Infant wide-field retinal image. Acquired on the Phoenix ICON. 1240x1240px.
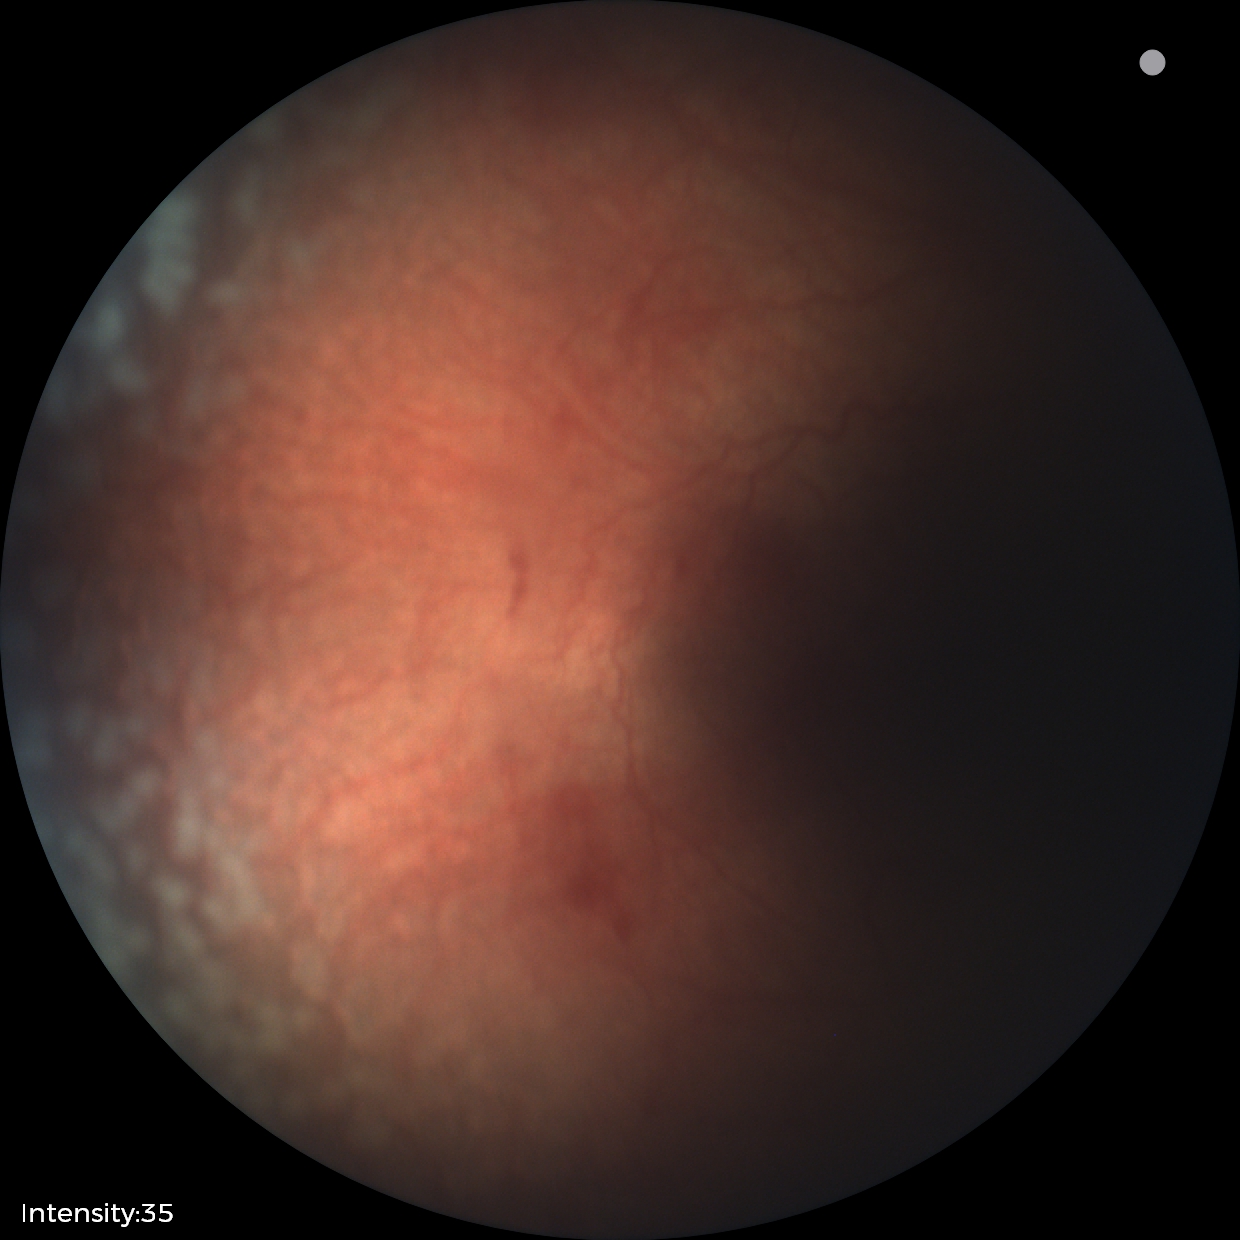
Screening diagnosis: plus disease | retinopathy of prematurity stage 2.